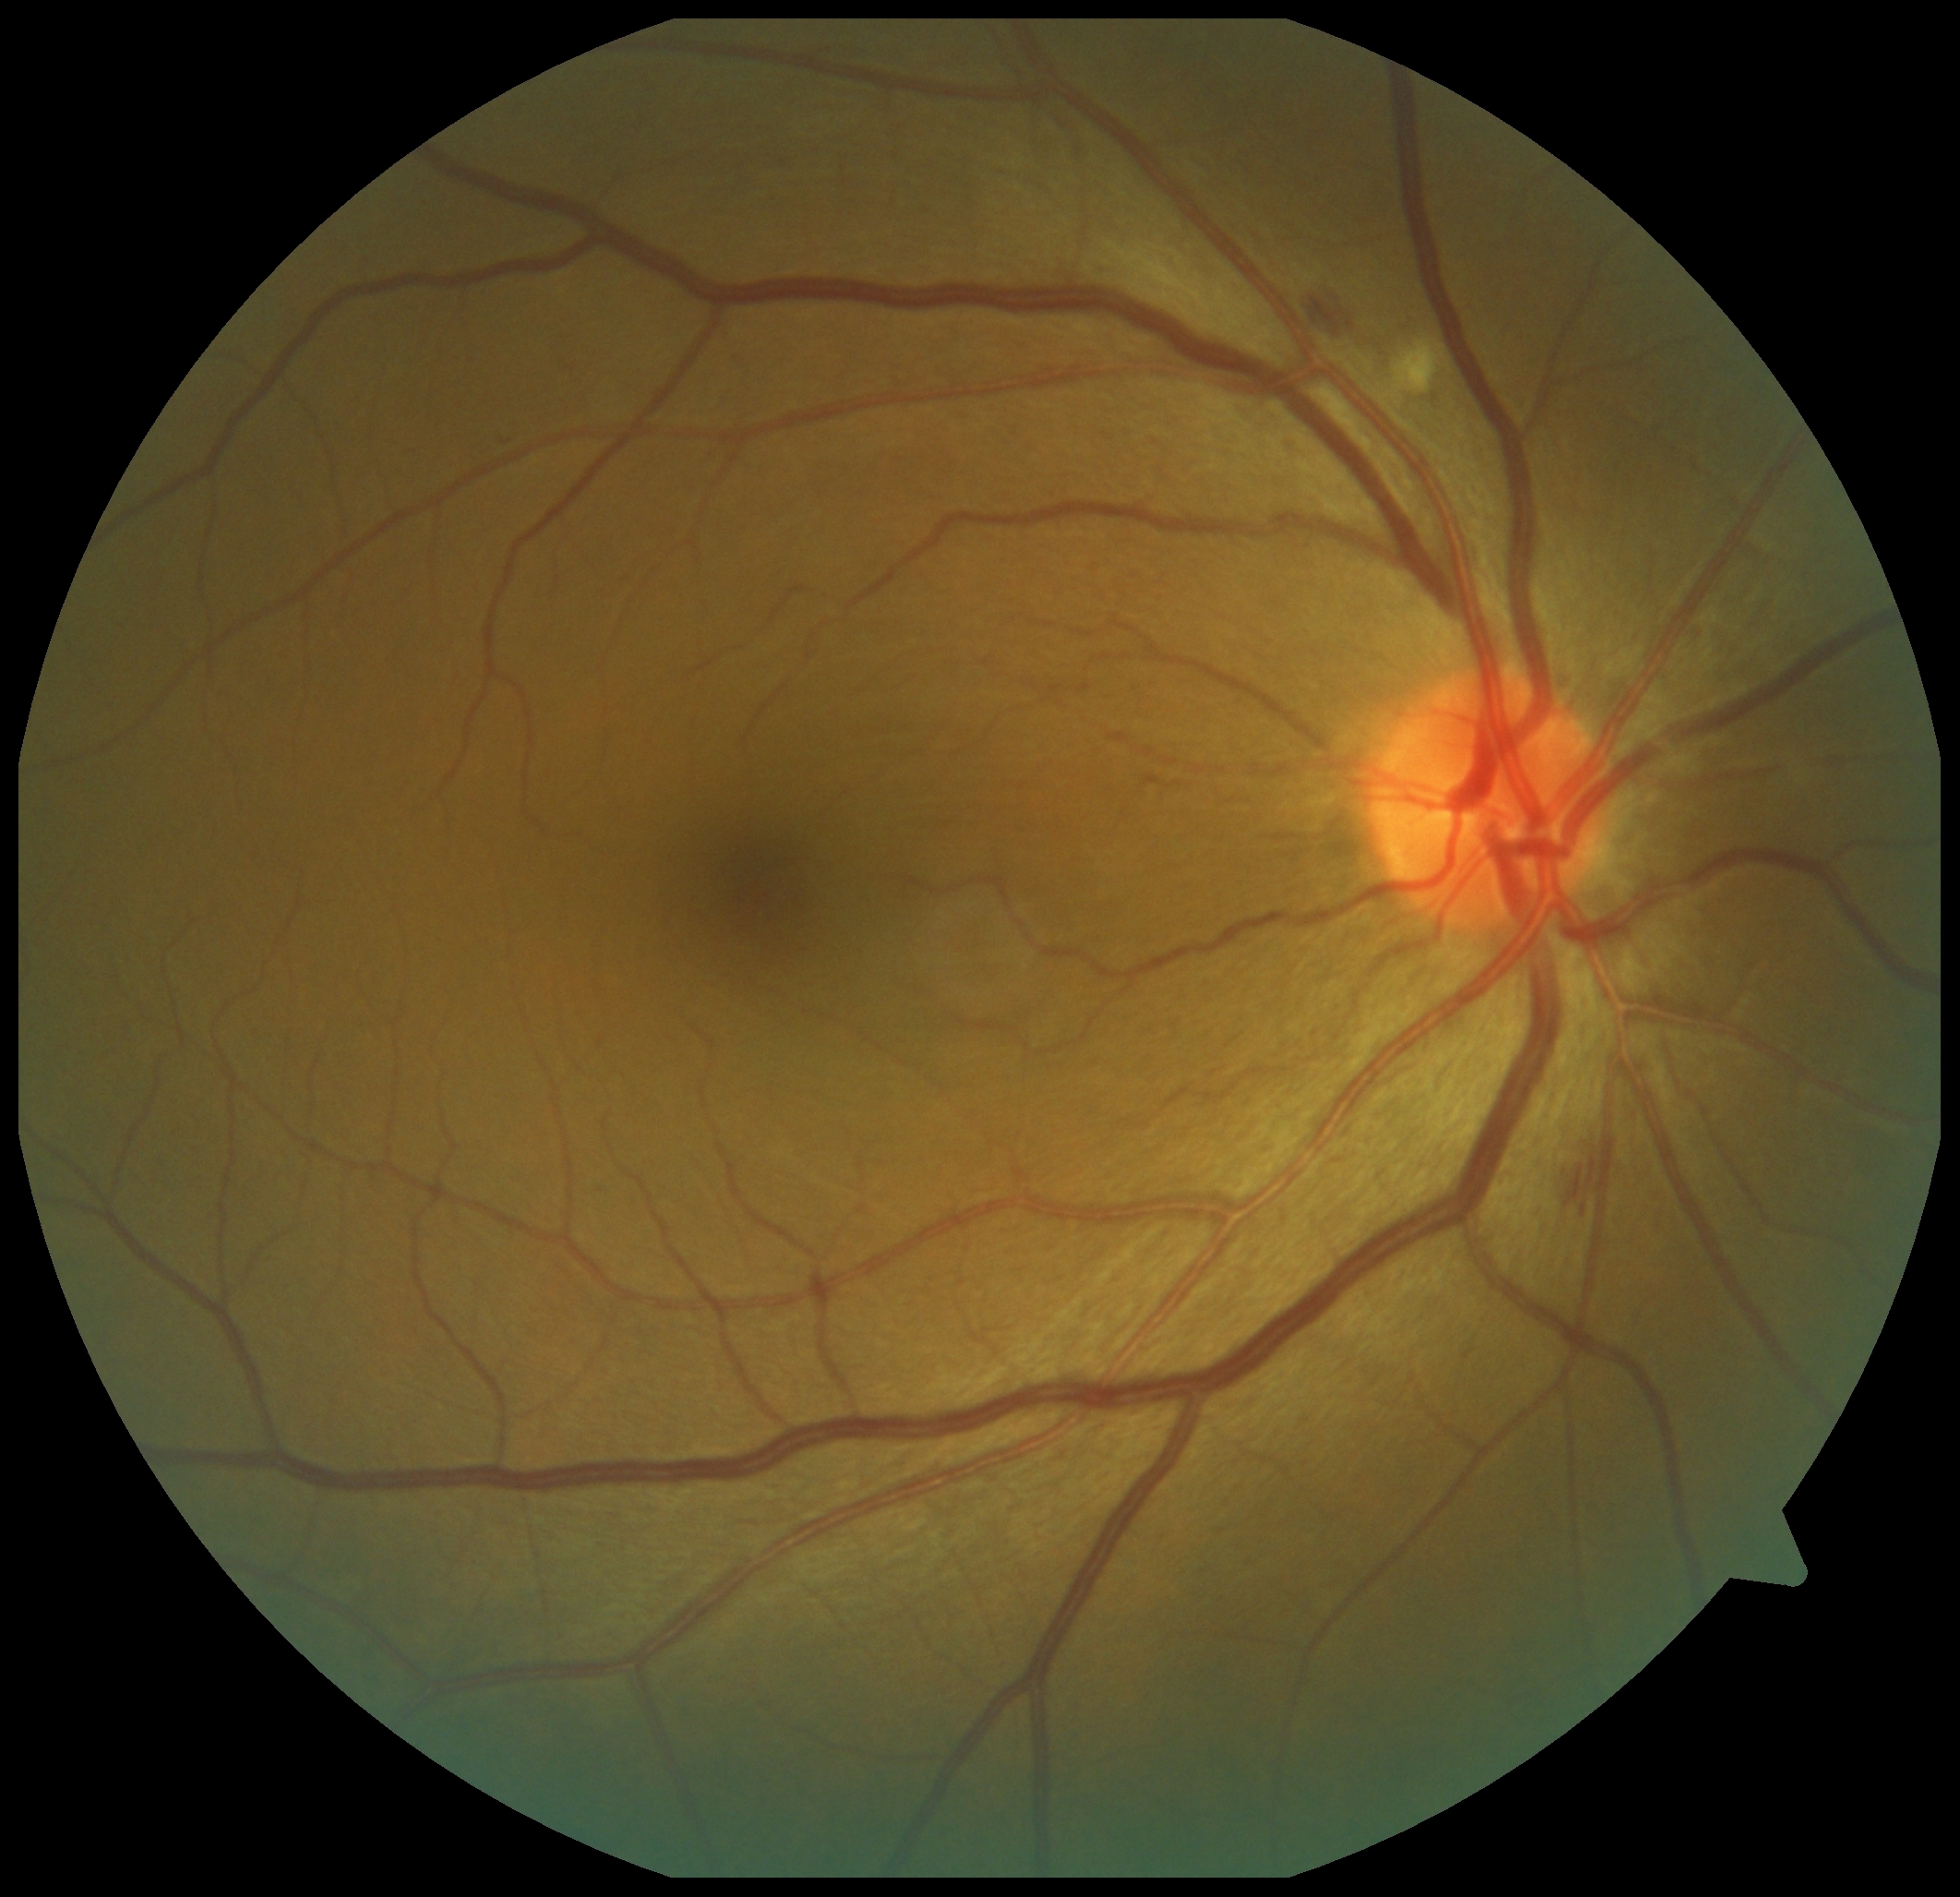 {"partial": true, "dr_grade": 2, "lesions": {"se": [[1399, 342, 1442, 399]], "ma": null, "he": [[1309, 290, 1359, 342], [1570, 1158, 1598, 1214]], "ex": null}}